Wide-field fundus image from infant ROP screening. 640x480px. 130° field of view (Clarity RetCam 3):
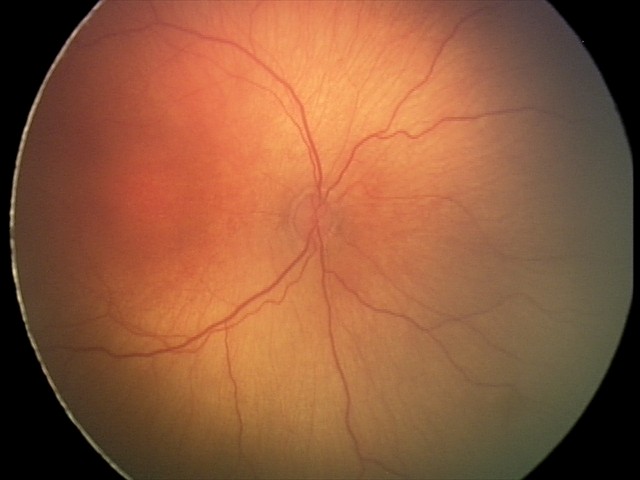 Diagnosis from this screening exam: ROP stage 2. Without plus disease.